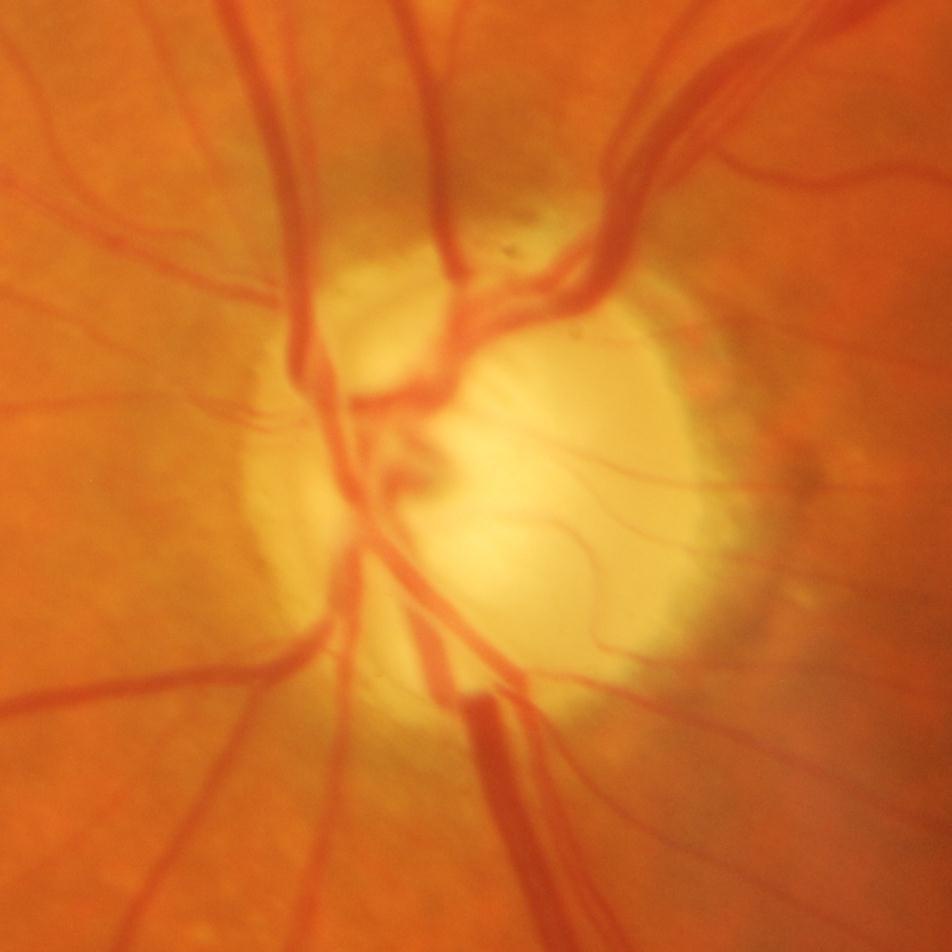
Glaucomatous changes are present.
Glaucomatous findings.